2102 by 1736 pixels — 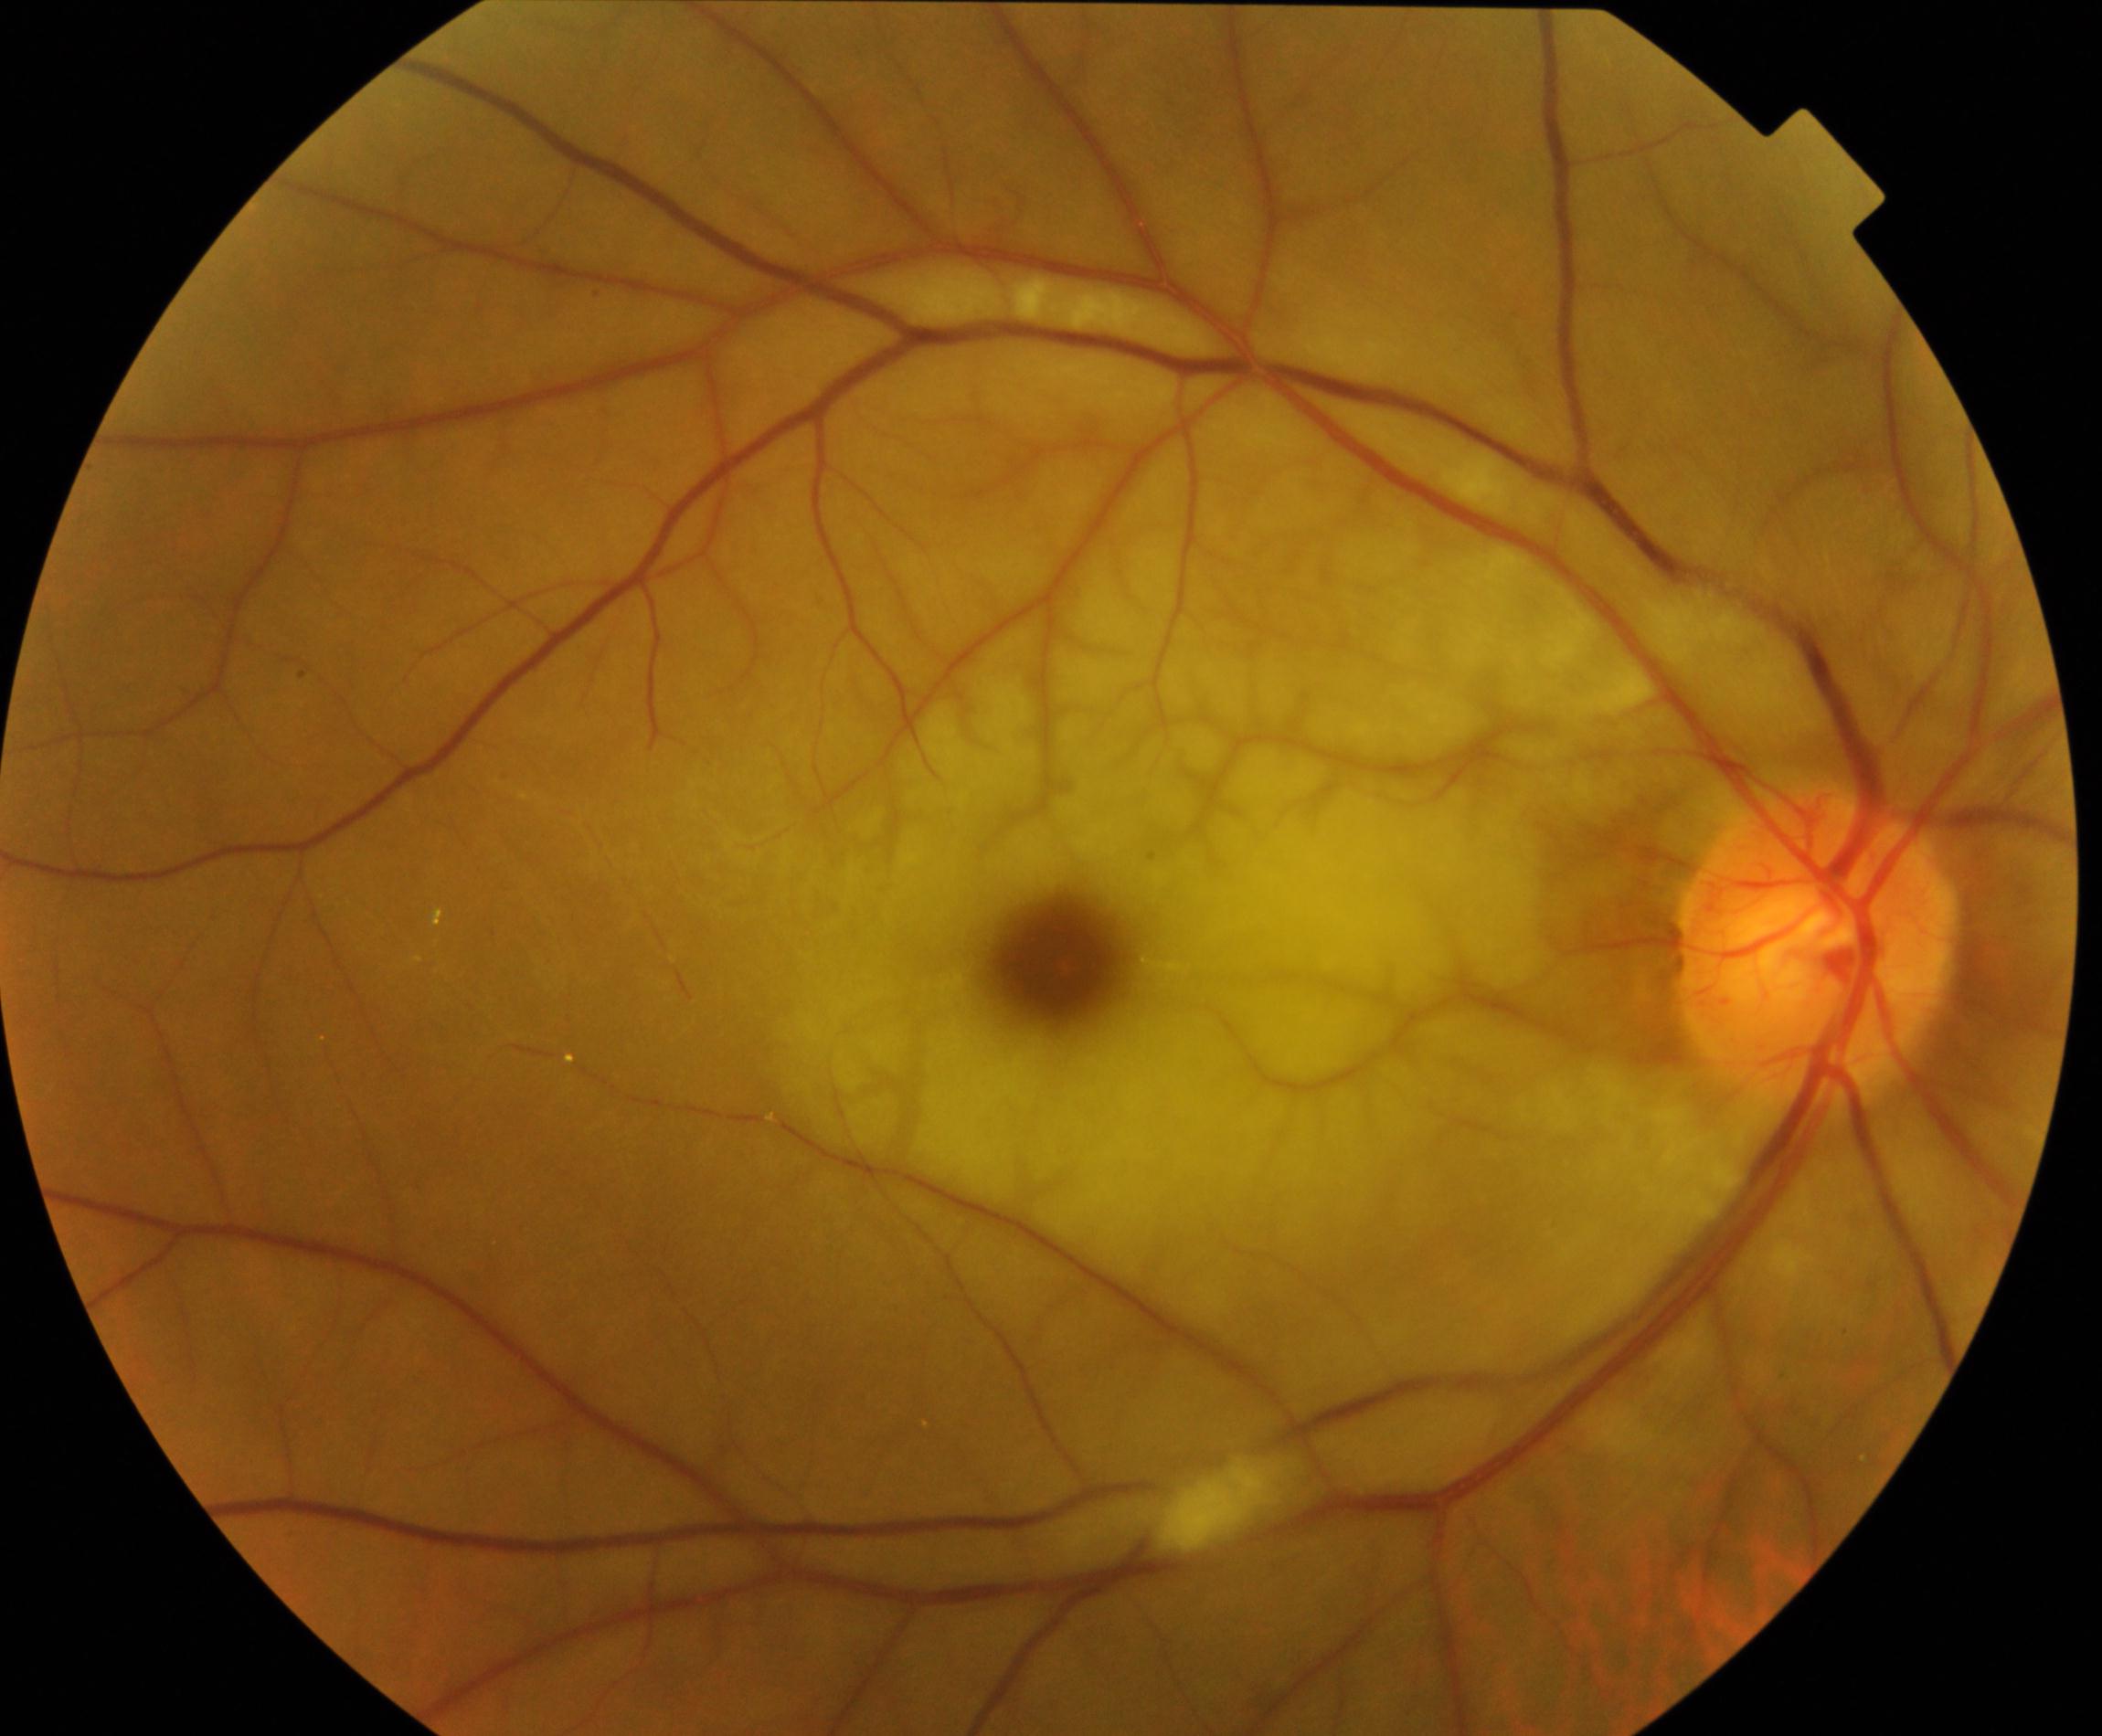
There is evidence of retinal artery occlusion.